FOV: 45 degrees. Color fundus image. 848x848px. Davis DR grading. Acquired with a NIDEK AFC-230: 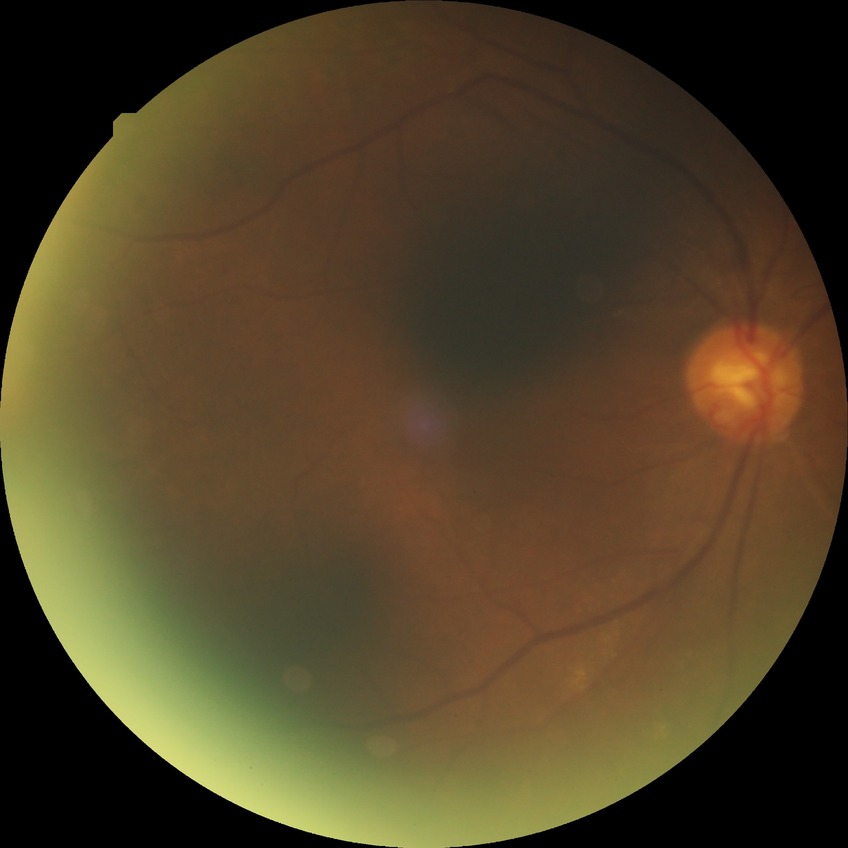 Assessment:
- retinopathy grade: proliferative diabetic retinopathy